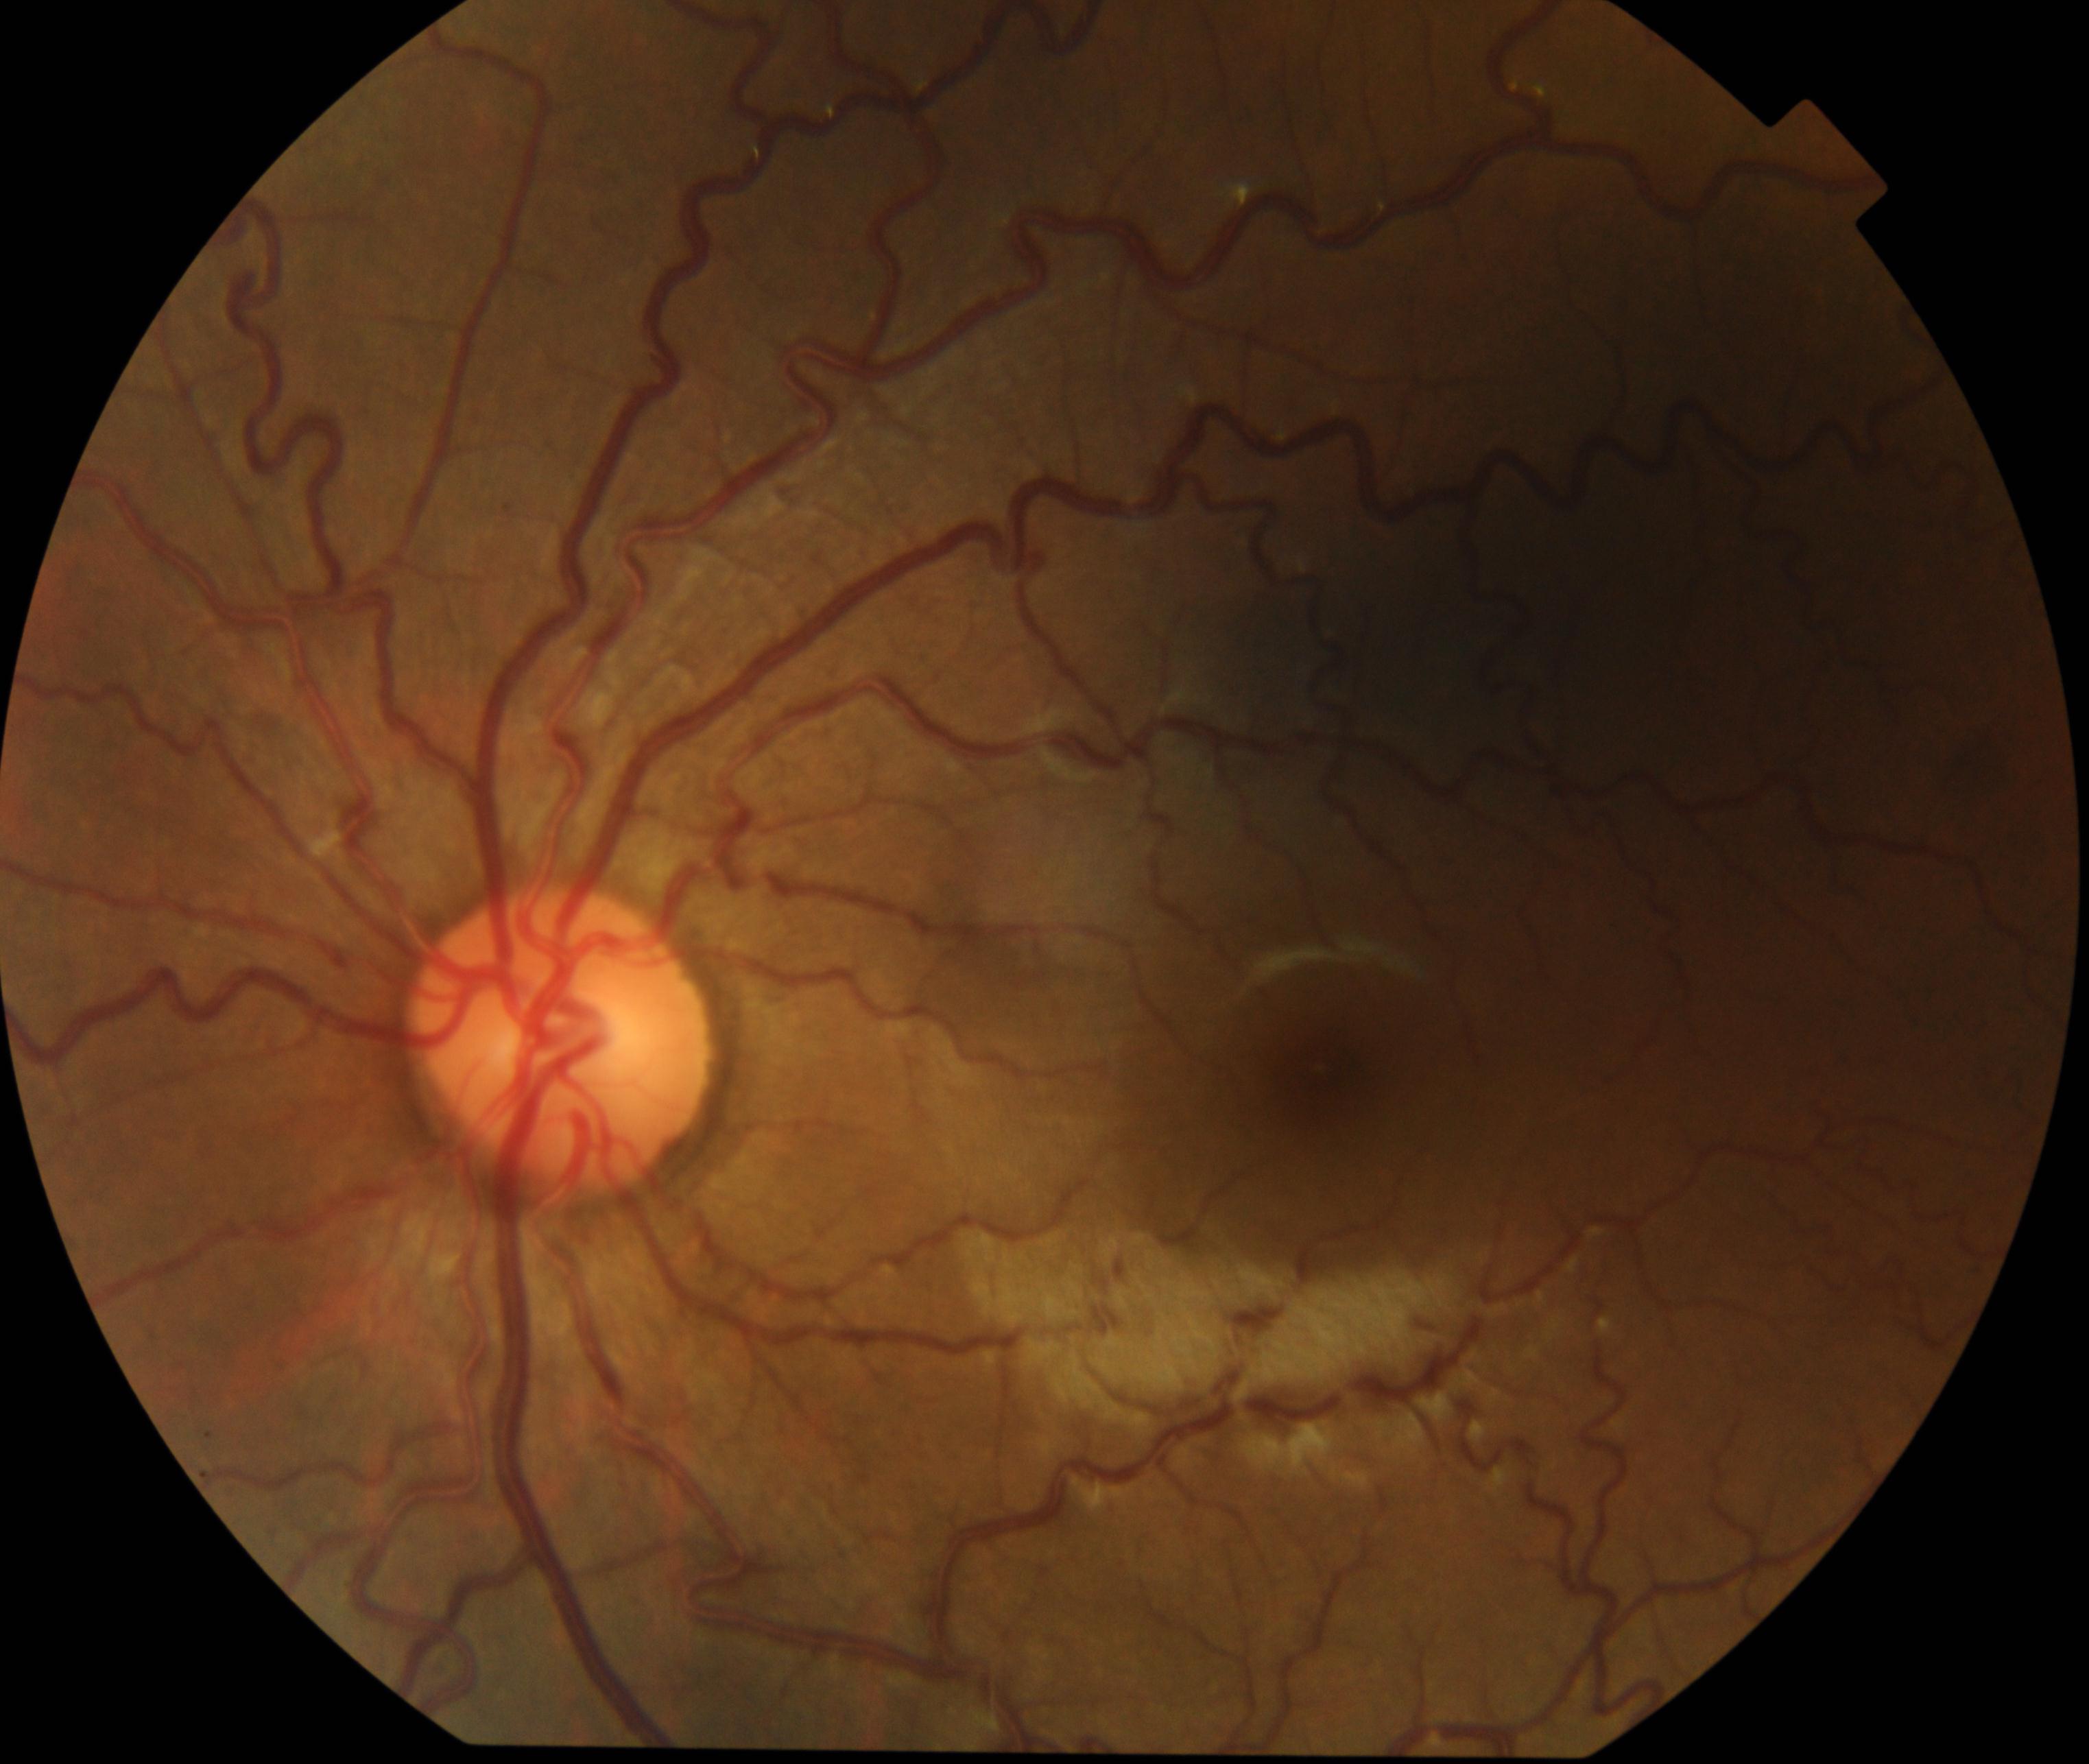

Impression: vessel tortuosity.